45° field of view
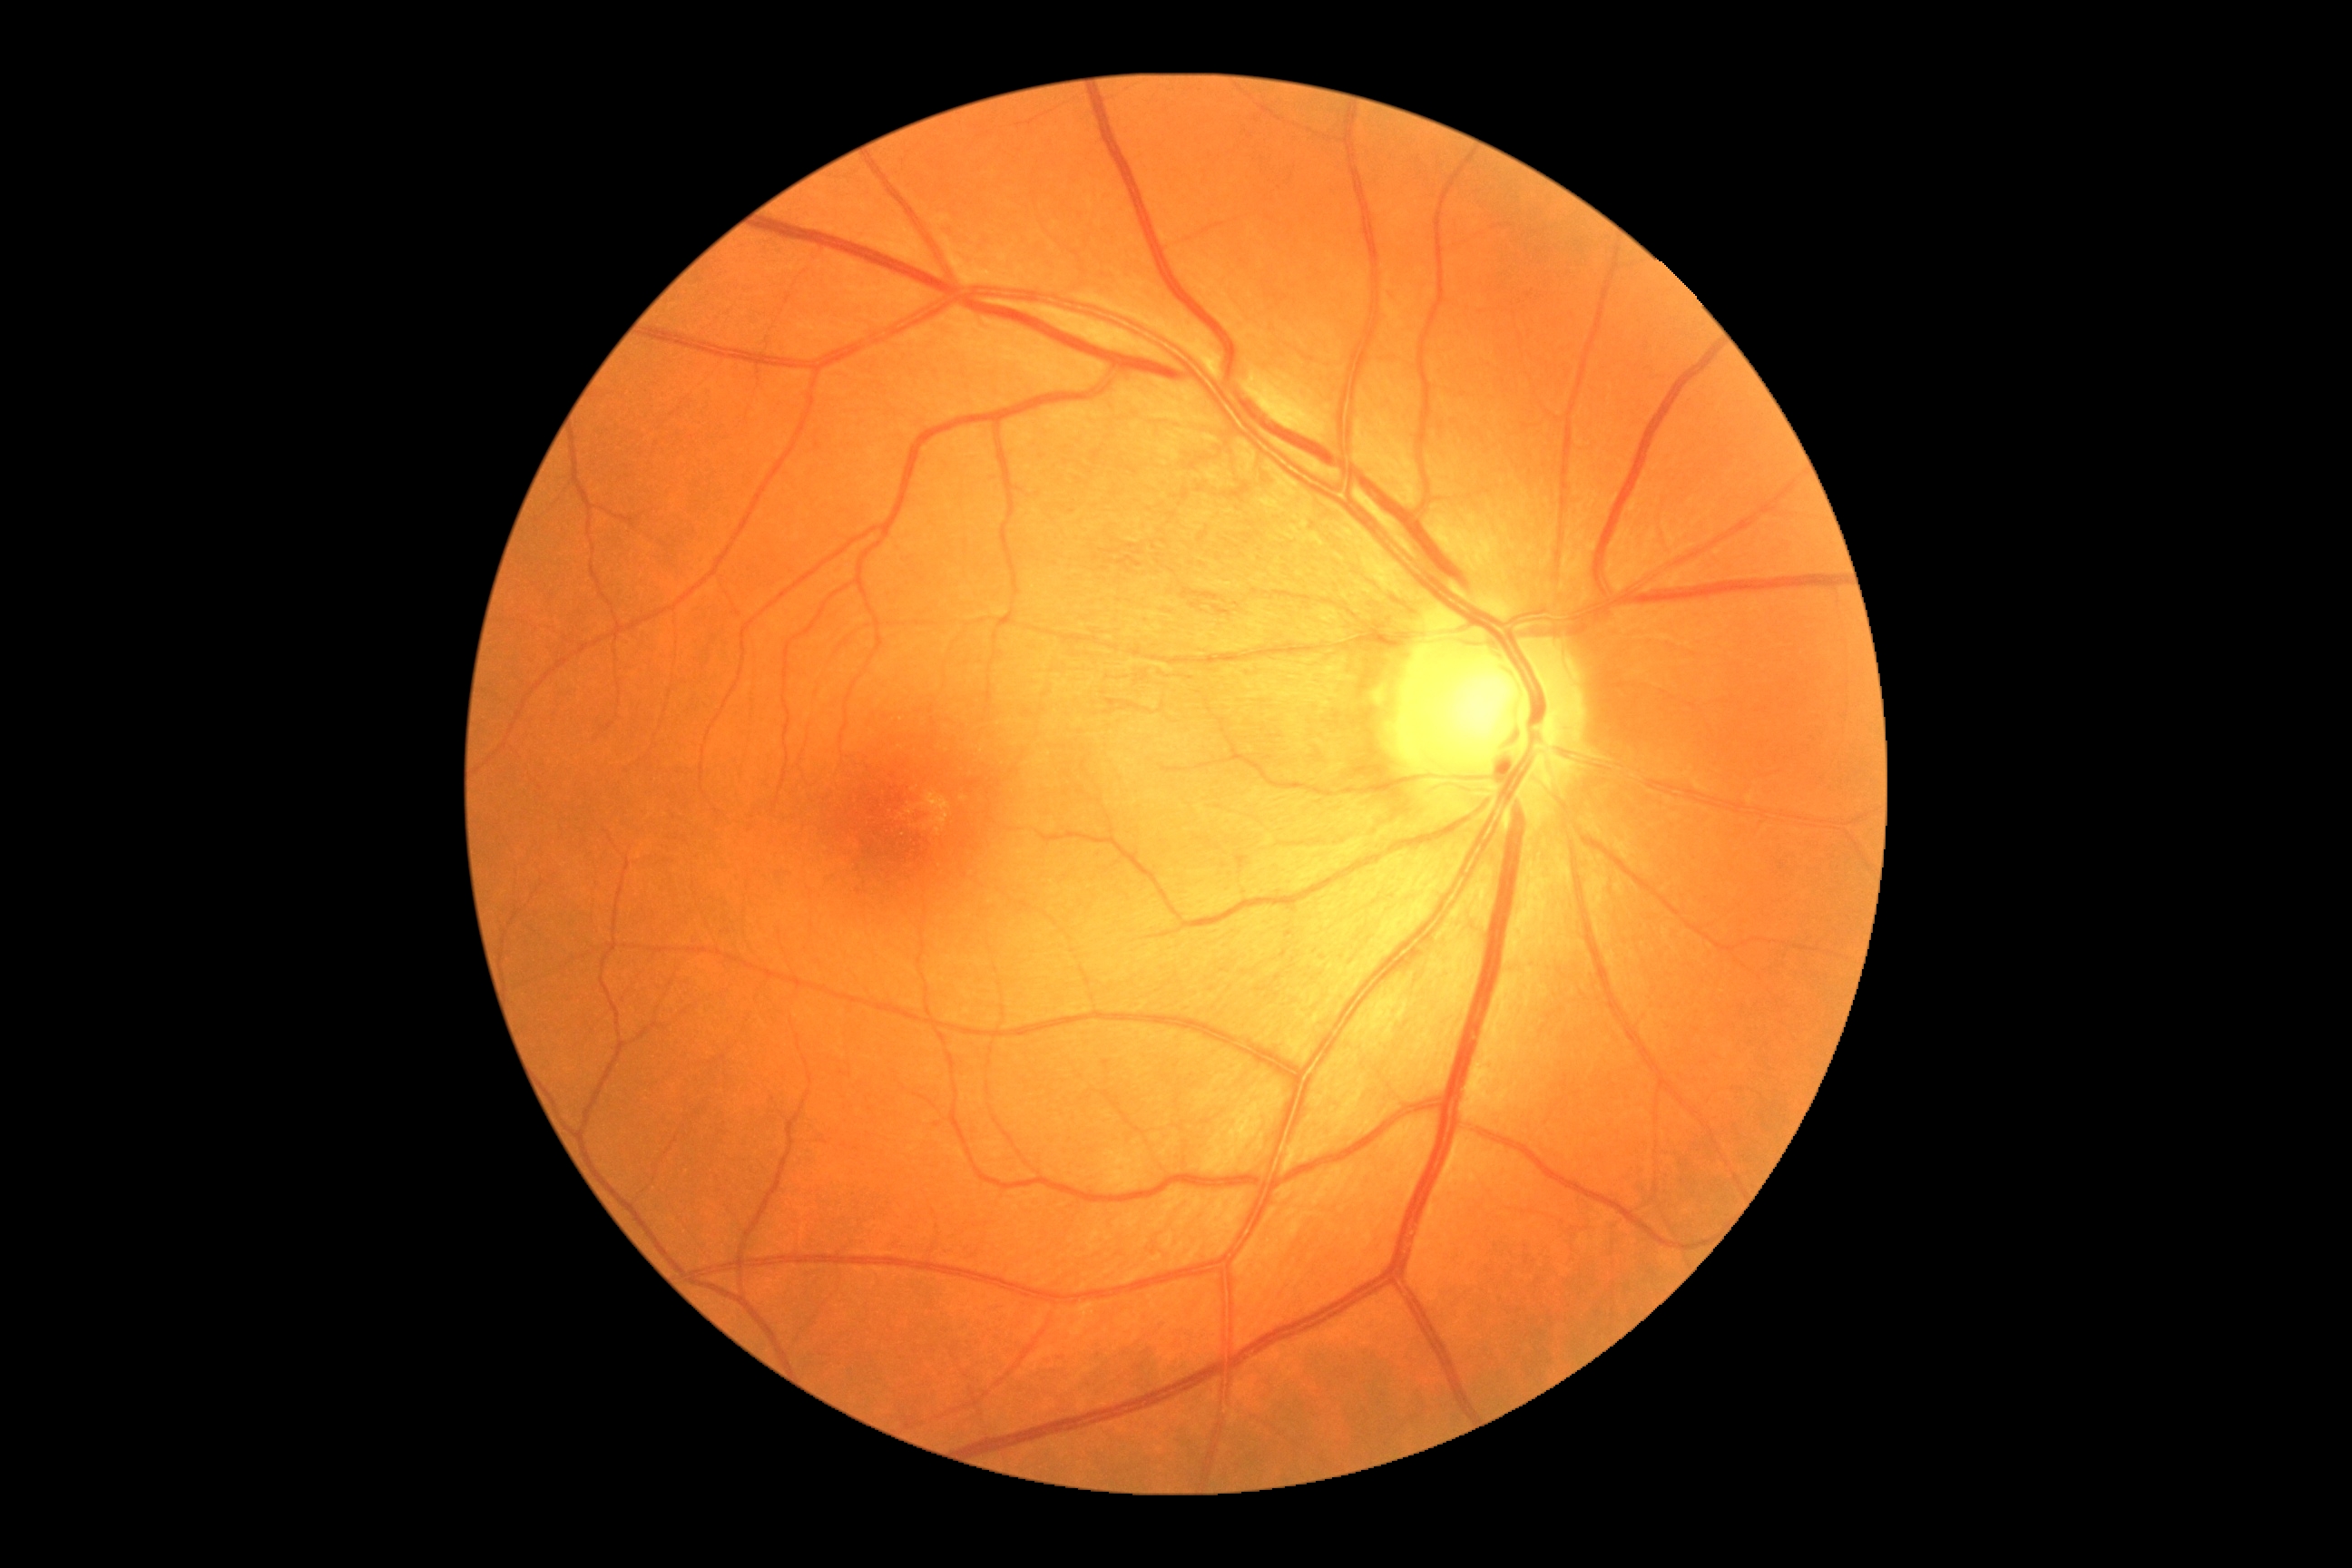 Diabetic retinopathy (DR) is 0/4.
No diabetic retinal disease findings.